Disc-centered fundus crop · 35° field of view before cropping:
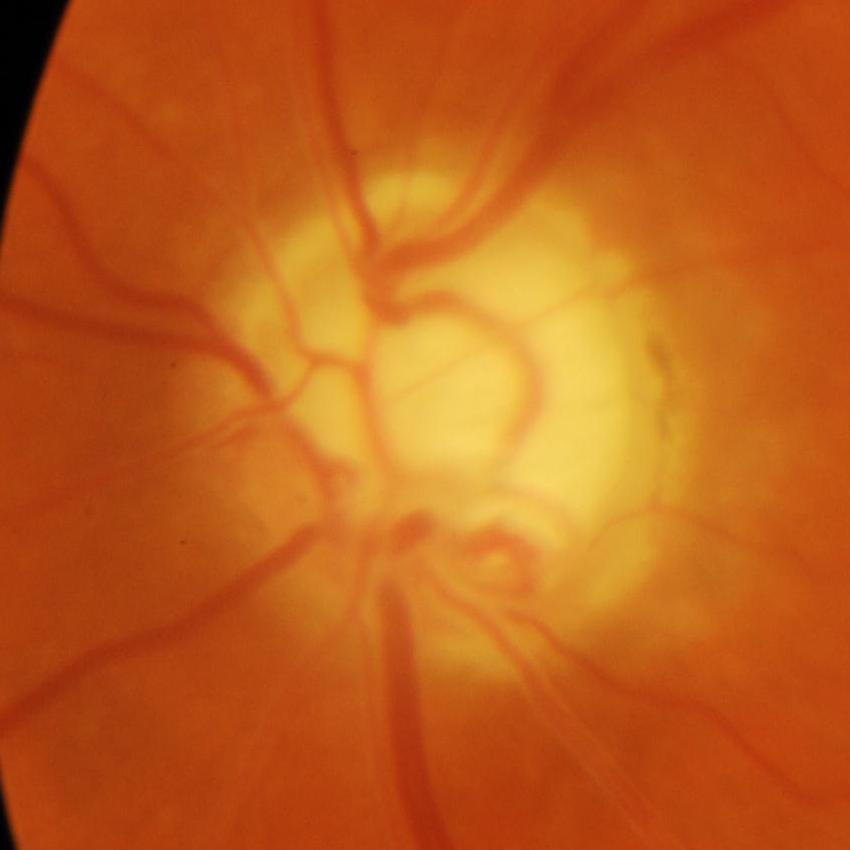
Q: Is there glaucomatous optic neuropathy?
A: Yes — glaucoma.